Color fundus image
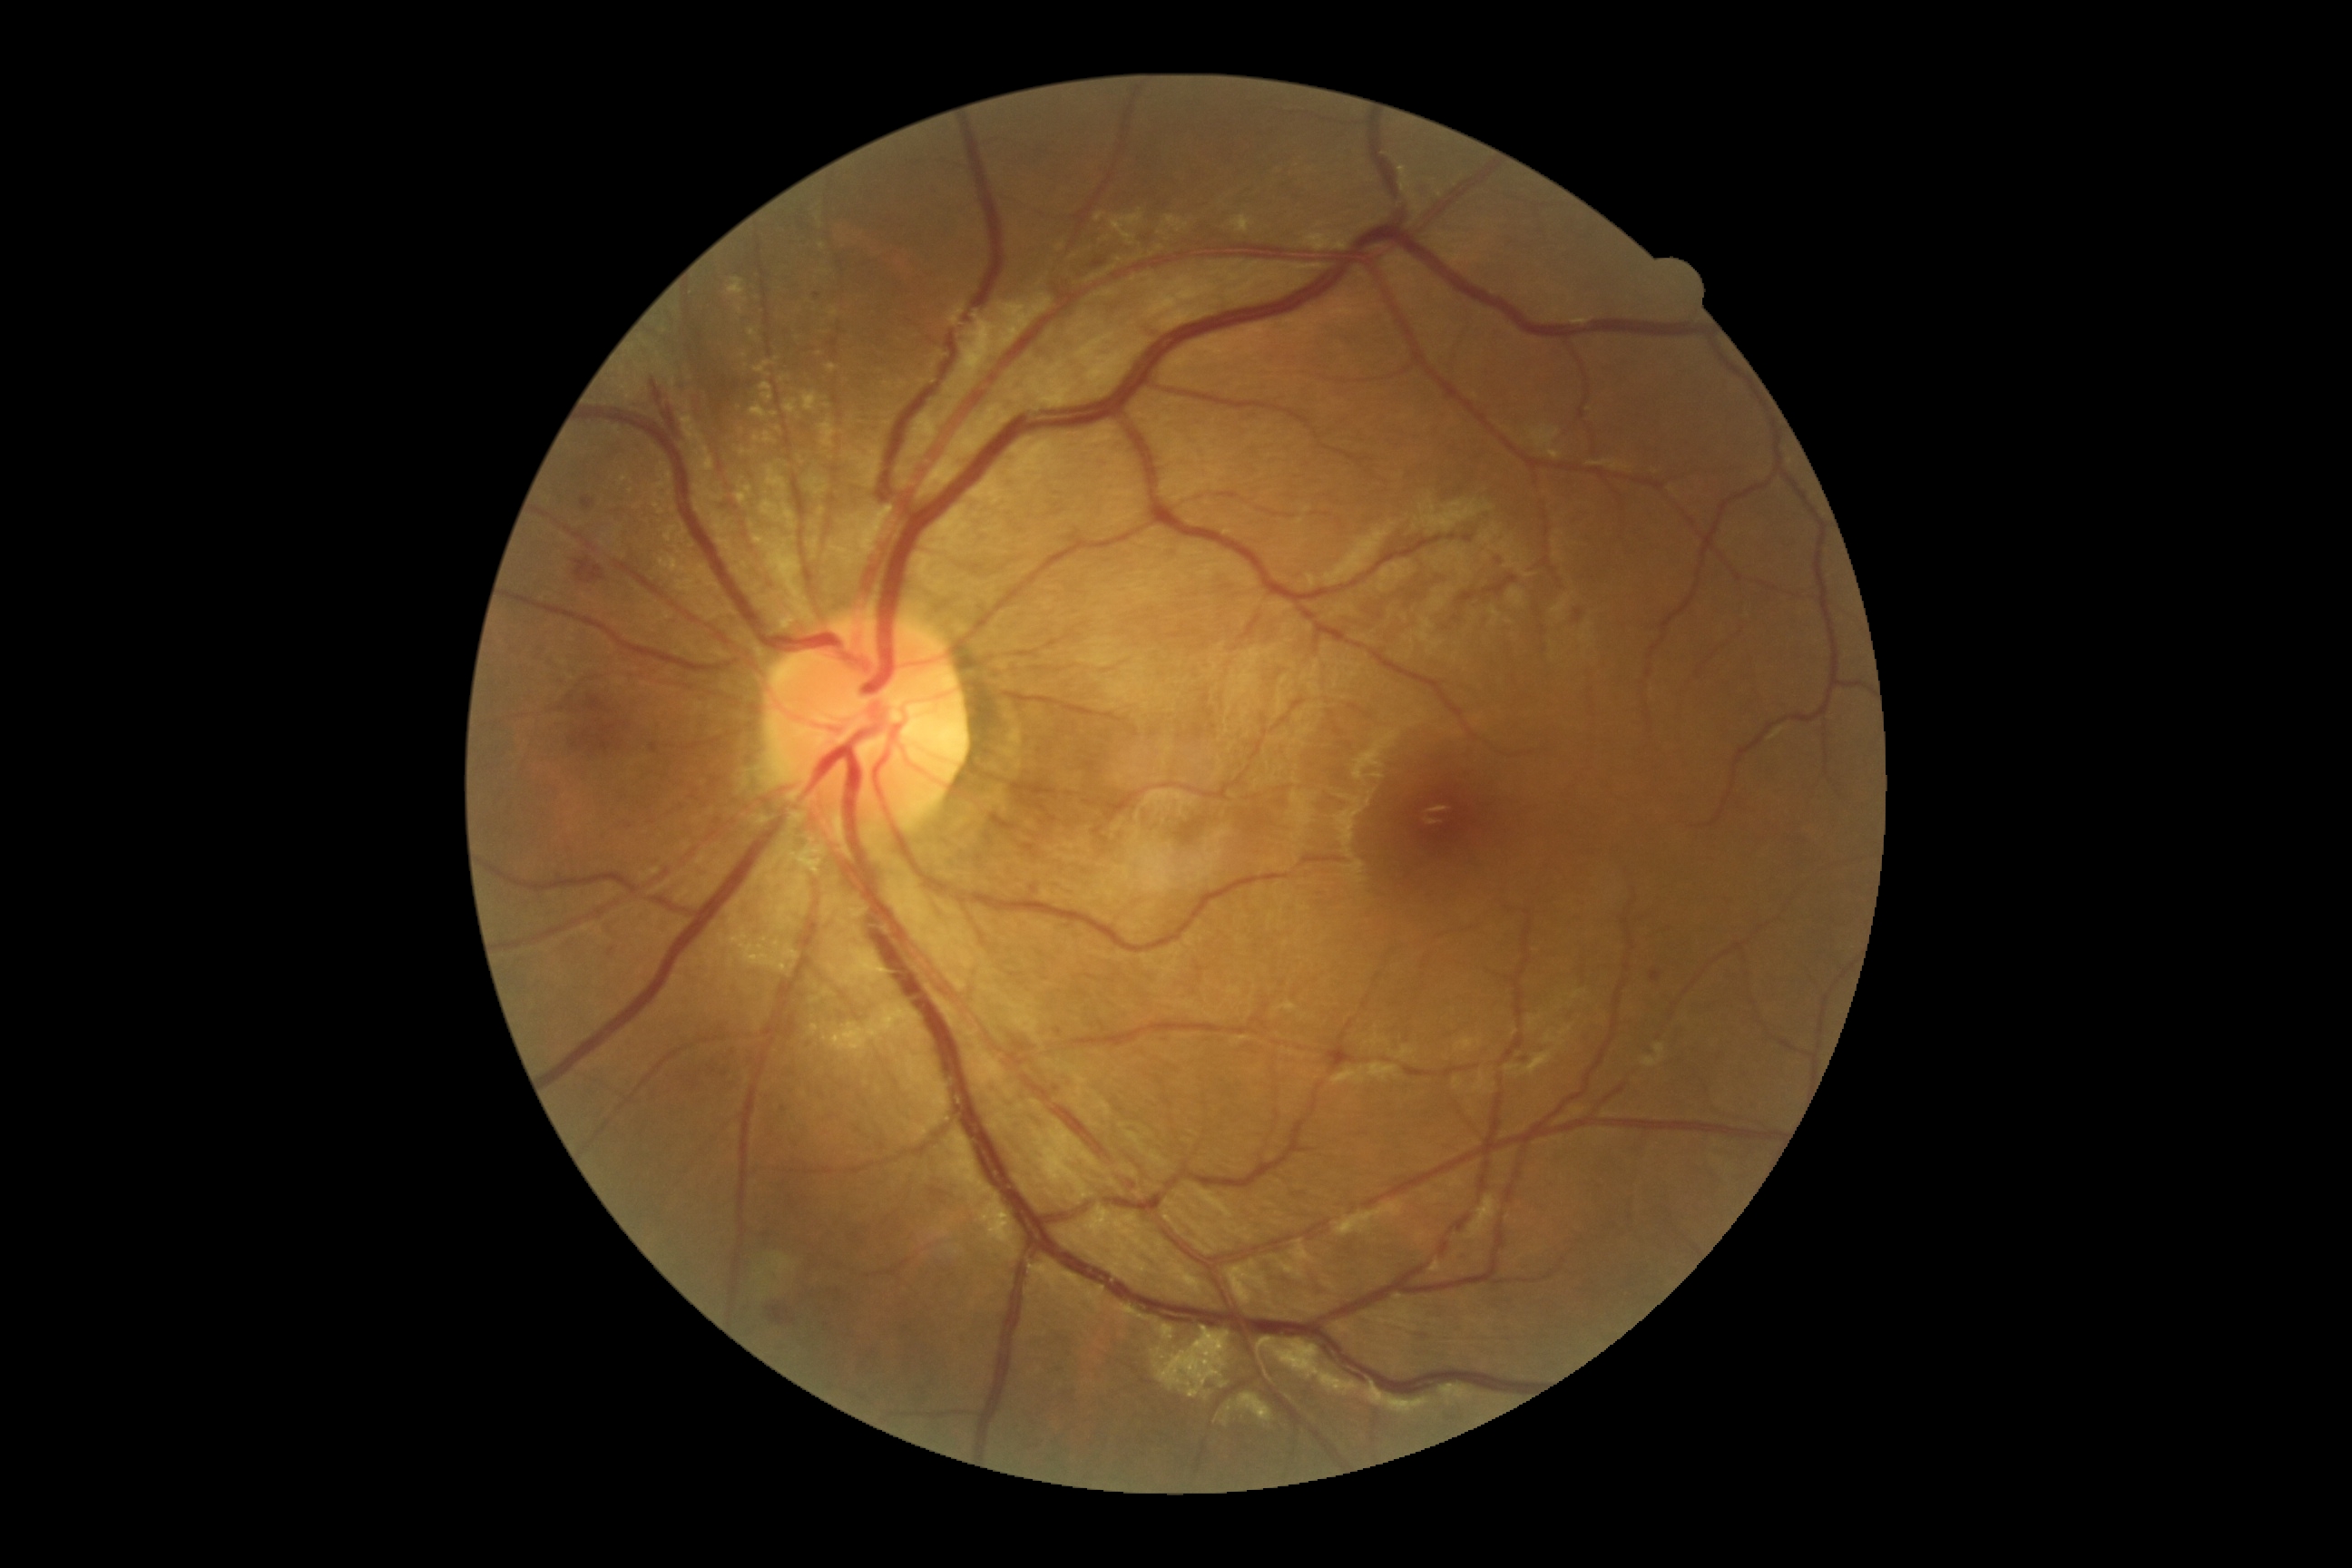 {"dr_grade": "moderate non-proliferative diabetic retinopathy (grade 2)"}